Portable fundus camera image:
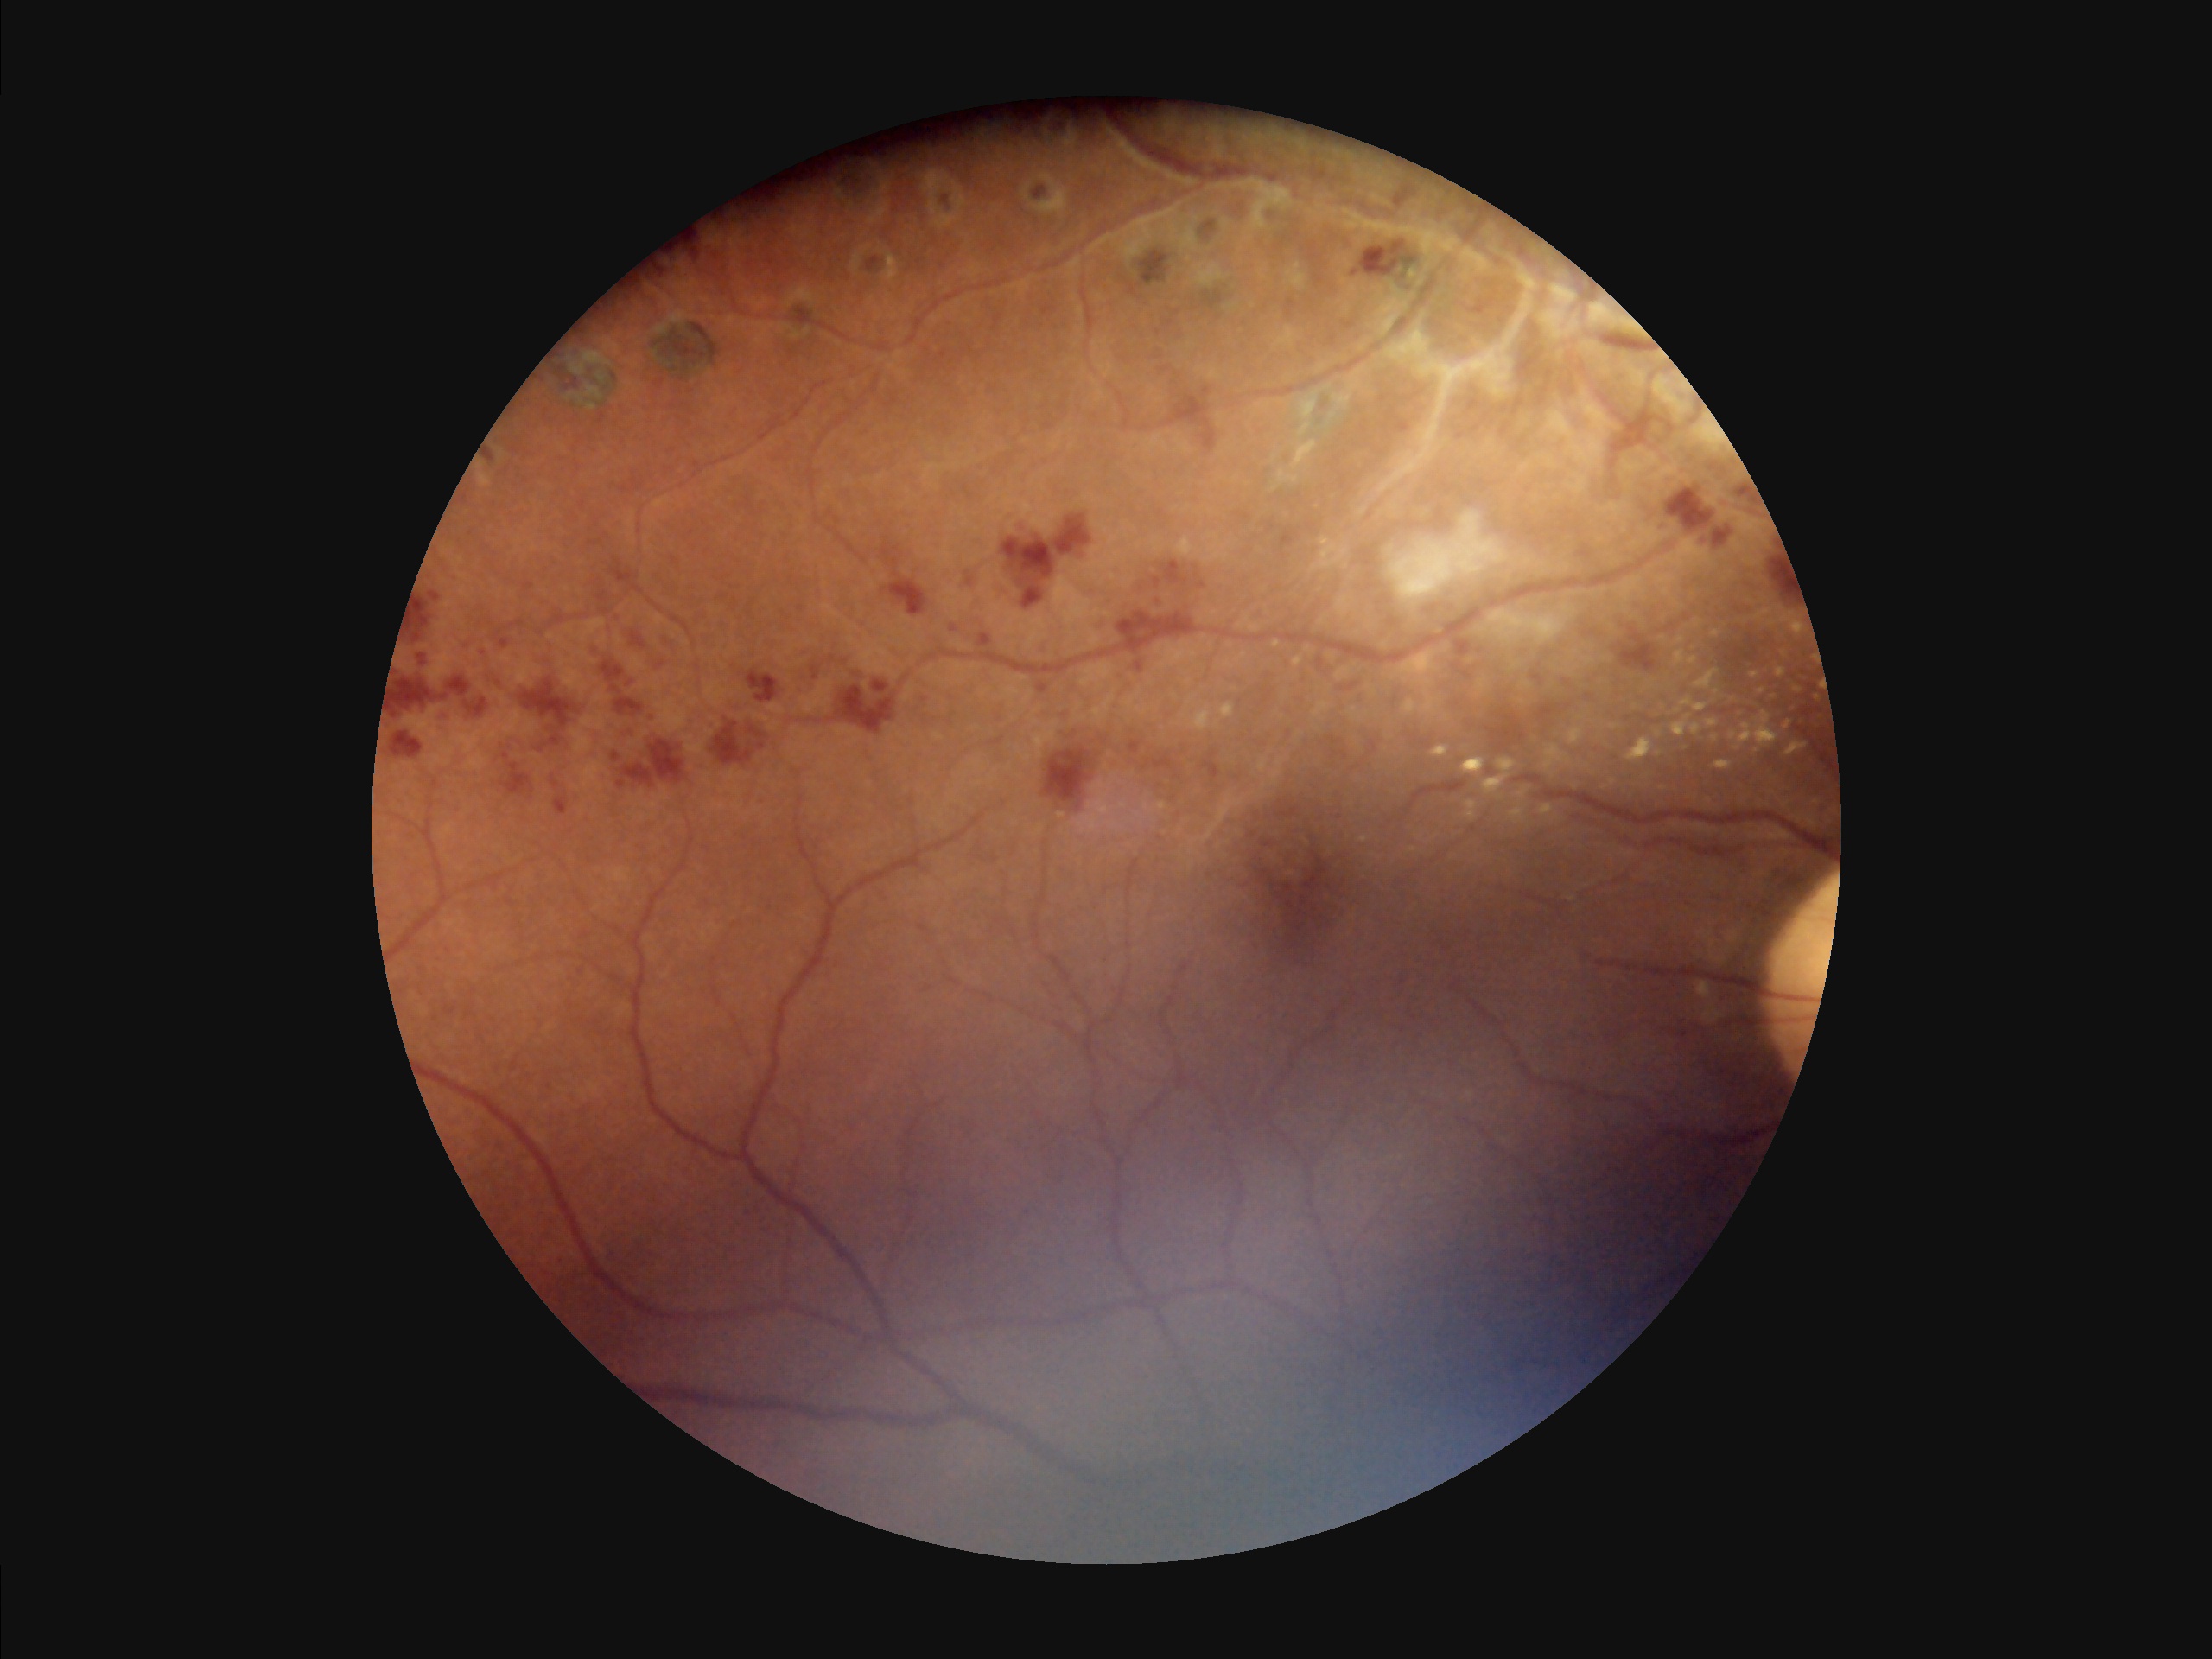
Illumination: over- or under-exposed; Sharpness: noticeable blur in the optic disc, vessels, or background; Overall image quality: good, gradable; Contrast: vessels and details readily distinguishable.